Mydriatic (tropicamide phenylephrine 1.0%): 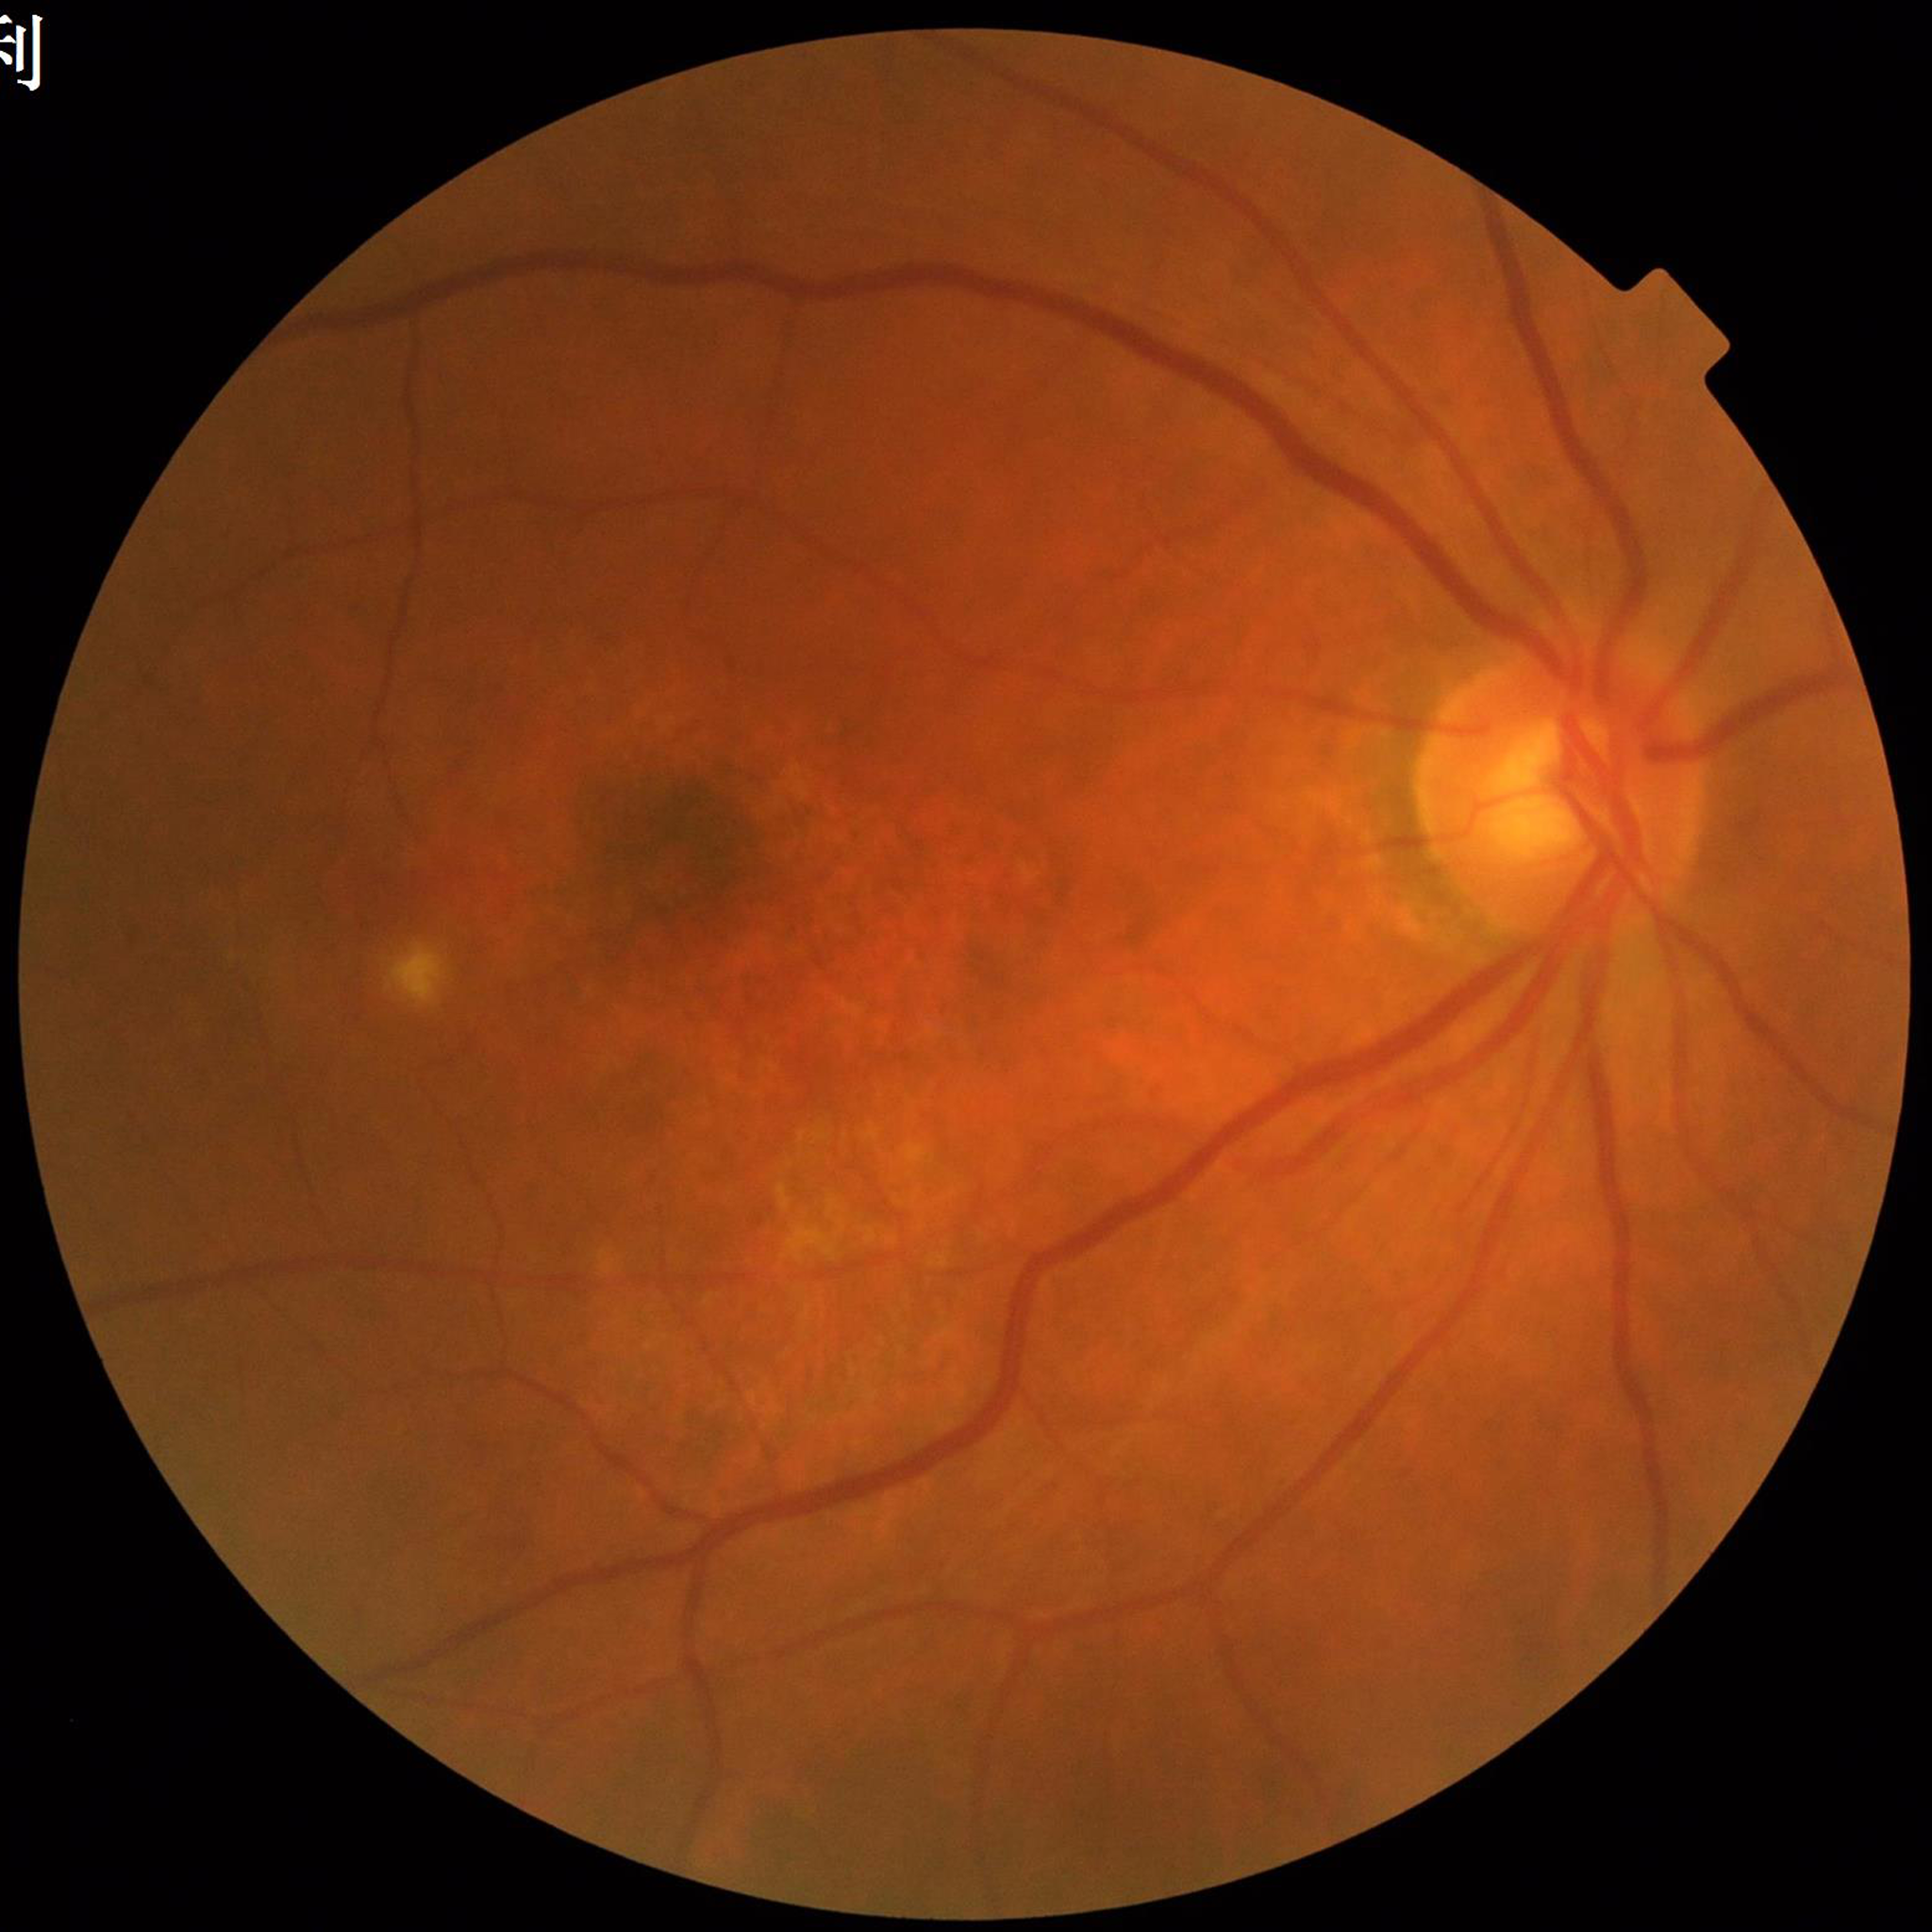 diagnosis: age-related macular degeneration